848x848. Camera: NIDEK AFC-230. Without pupil dilation. FOV: 45 degrees. Posterior pole color fundus photograph
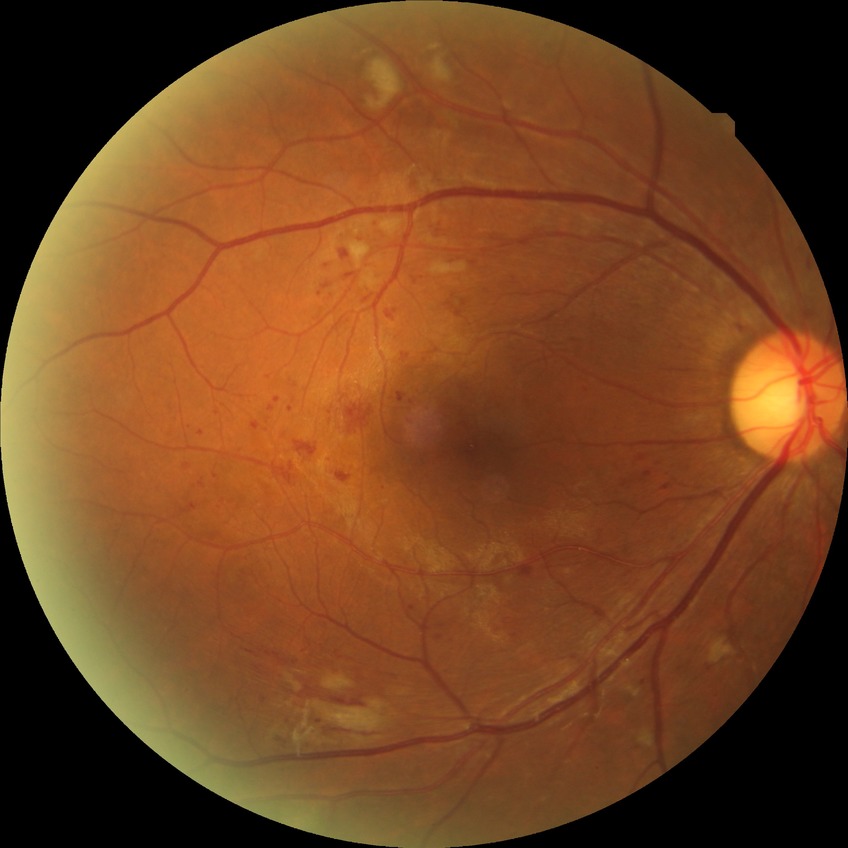

diabetic retinopathy (DR): PPDR (pre-proliferative diabetic retinopathy).